Nonmydriatic — 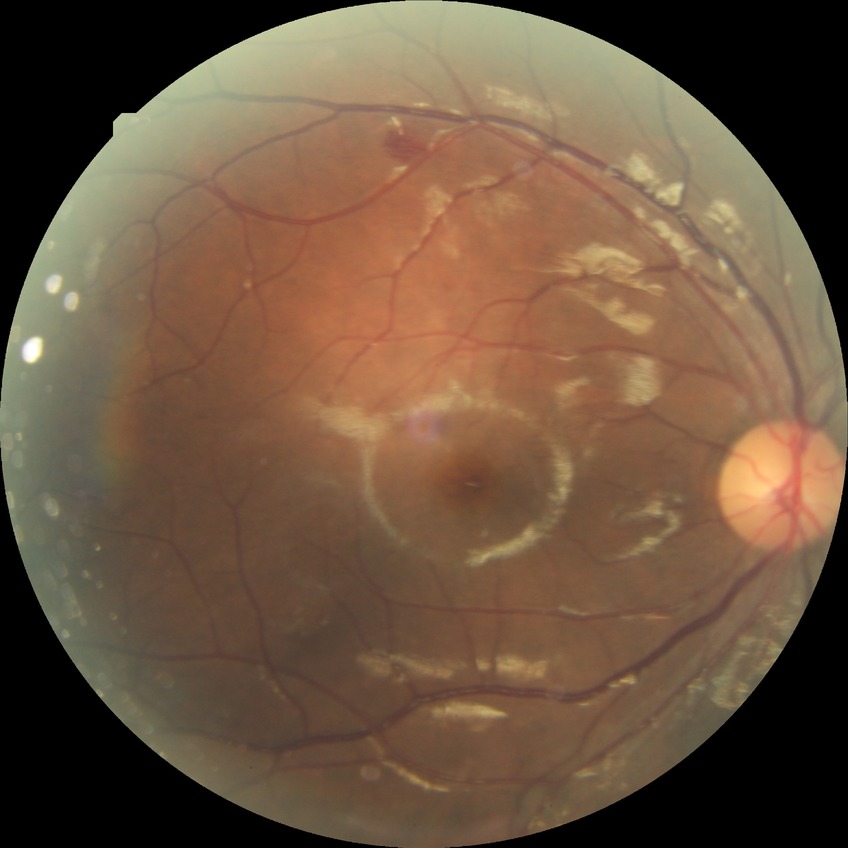

retinopathy grade: simple diabetic retinopathy.